Davis DR grading, 45° field of view — 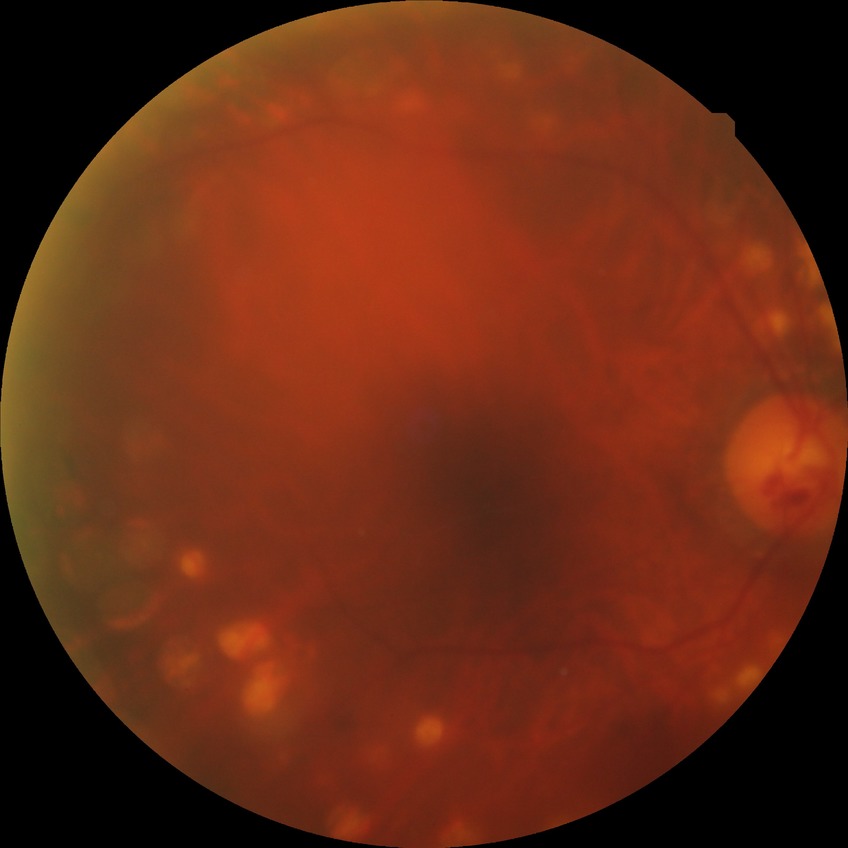 Diabetic retinopathy (DR): PDR (proliferative diabetic retinopathy).